FOV: 45 degrees. Without pupil dilation. Modified Davis grading
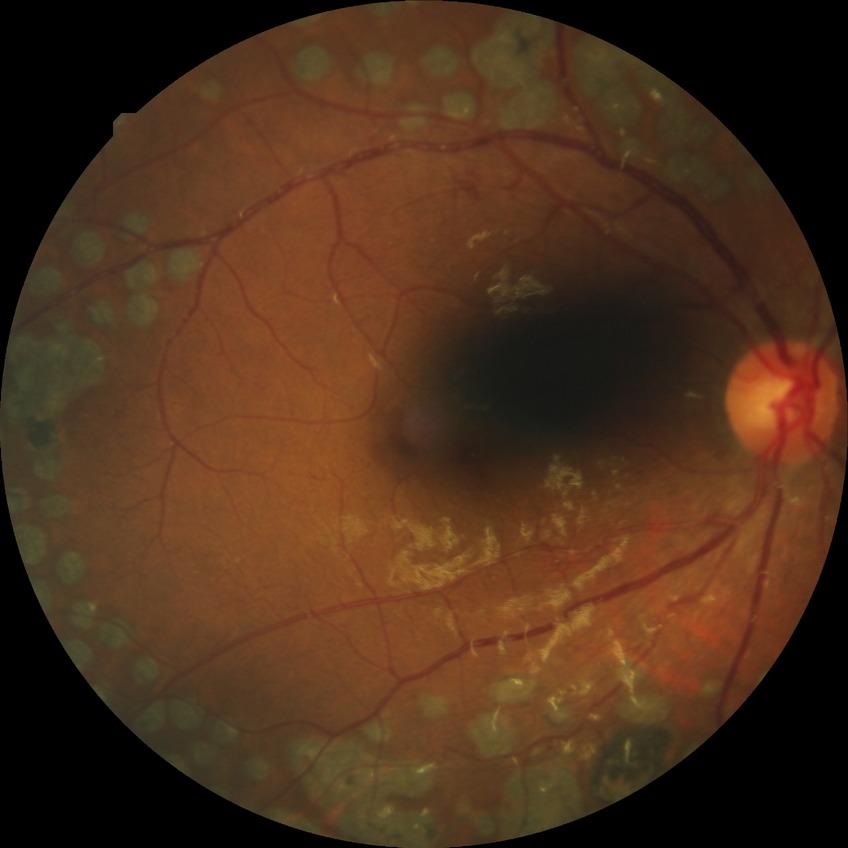
Diabetic retinopathy (DR): proliferative diabetic retinopathy (PDR).